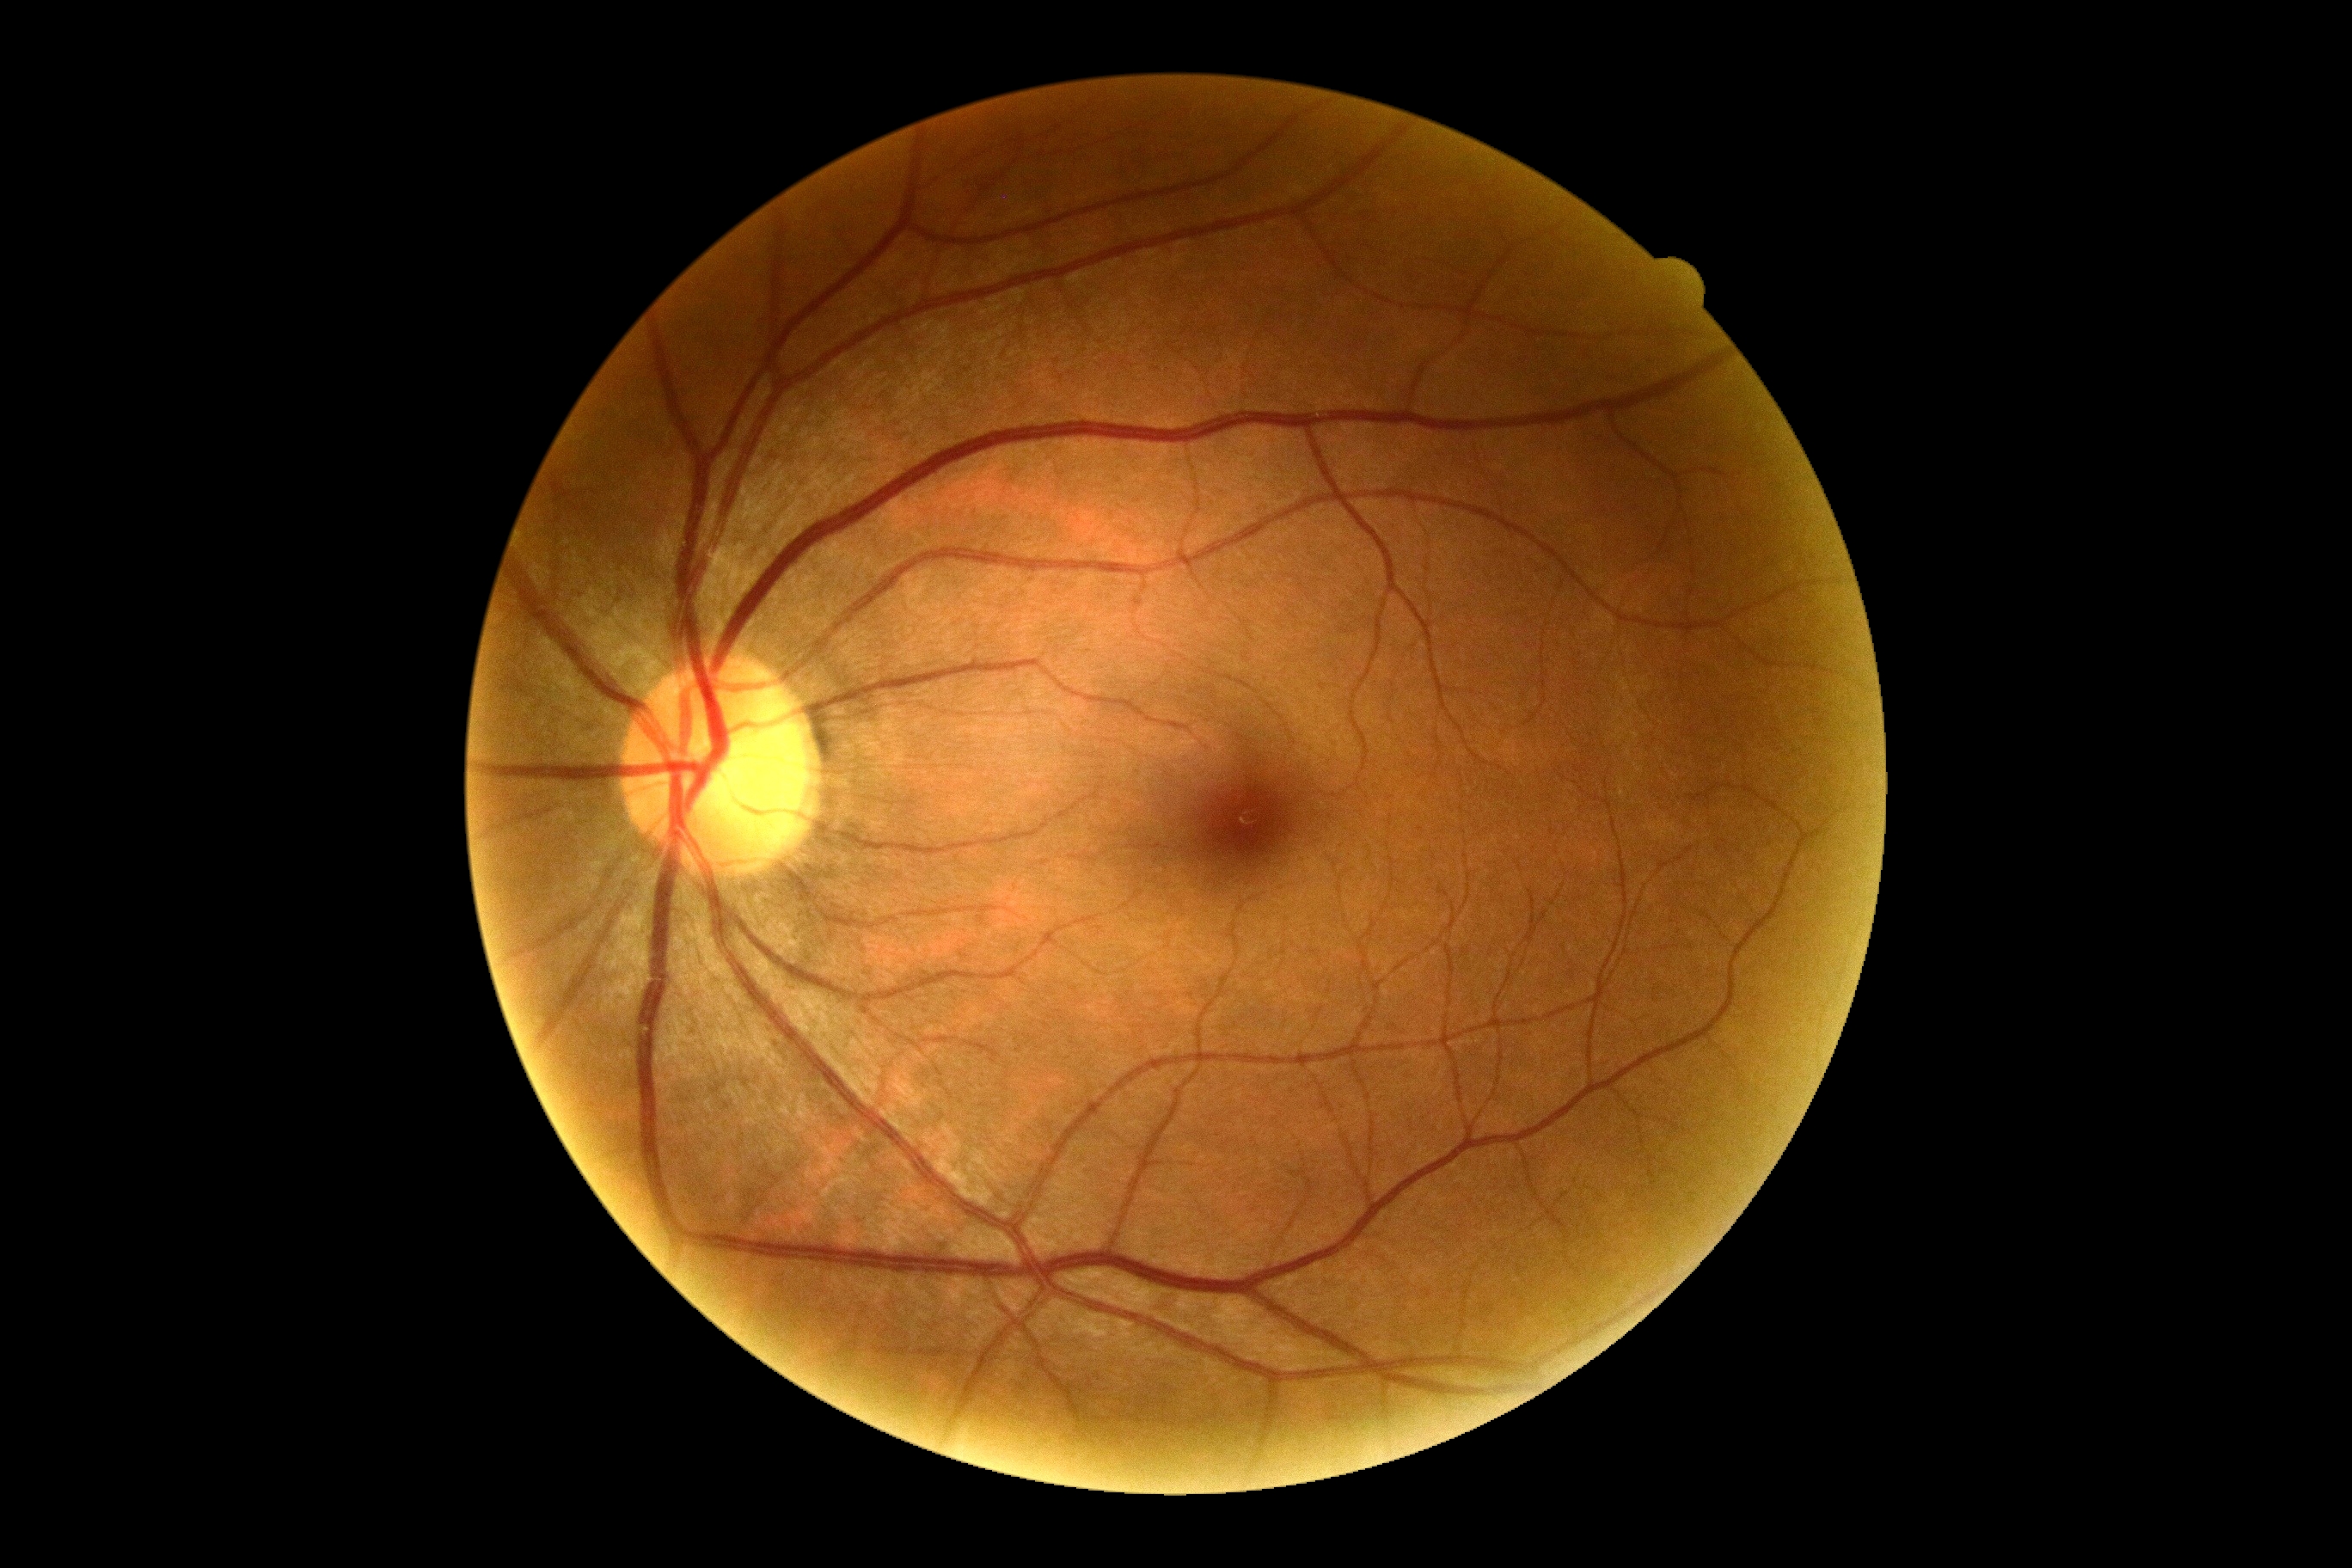

No signs of diabetic retinopathy. Diabetic retinopathy is 0/4.